Pediatric retinal photograph (wide-field) — 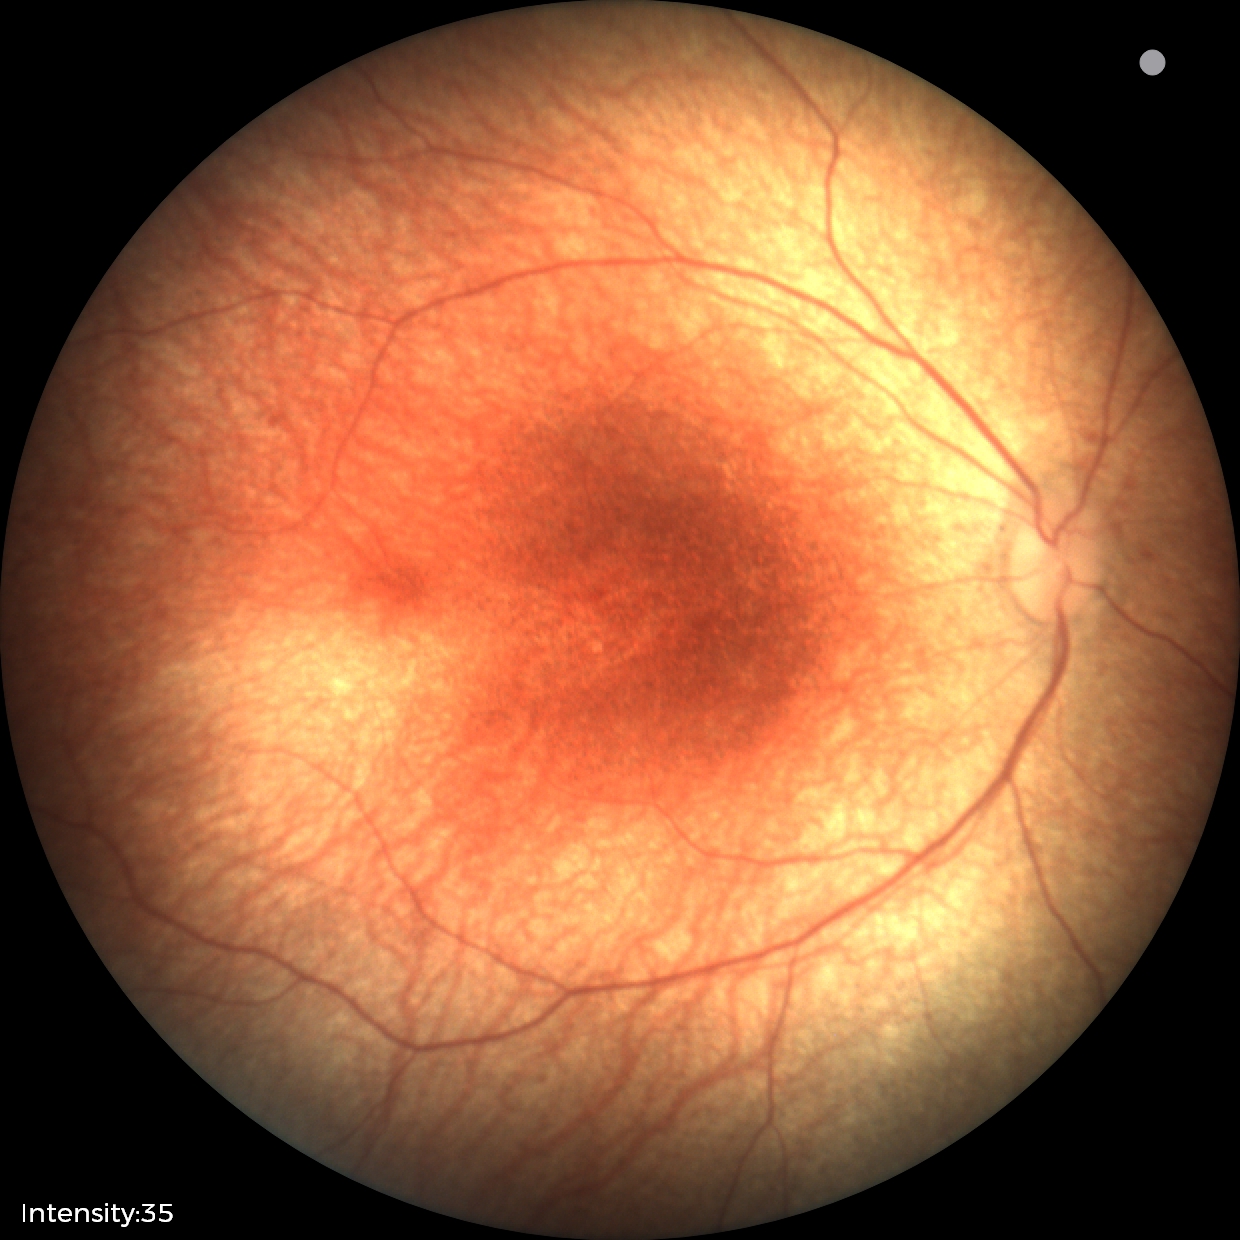 Examination with physiological retinal findings.